Pediatric wide-field fundus photograph:
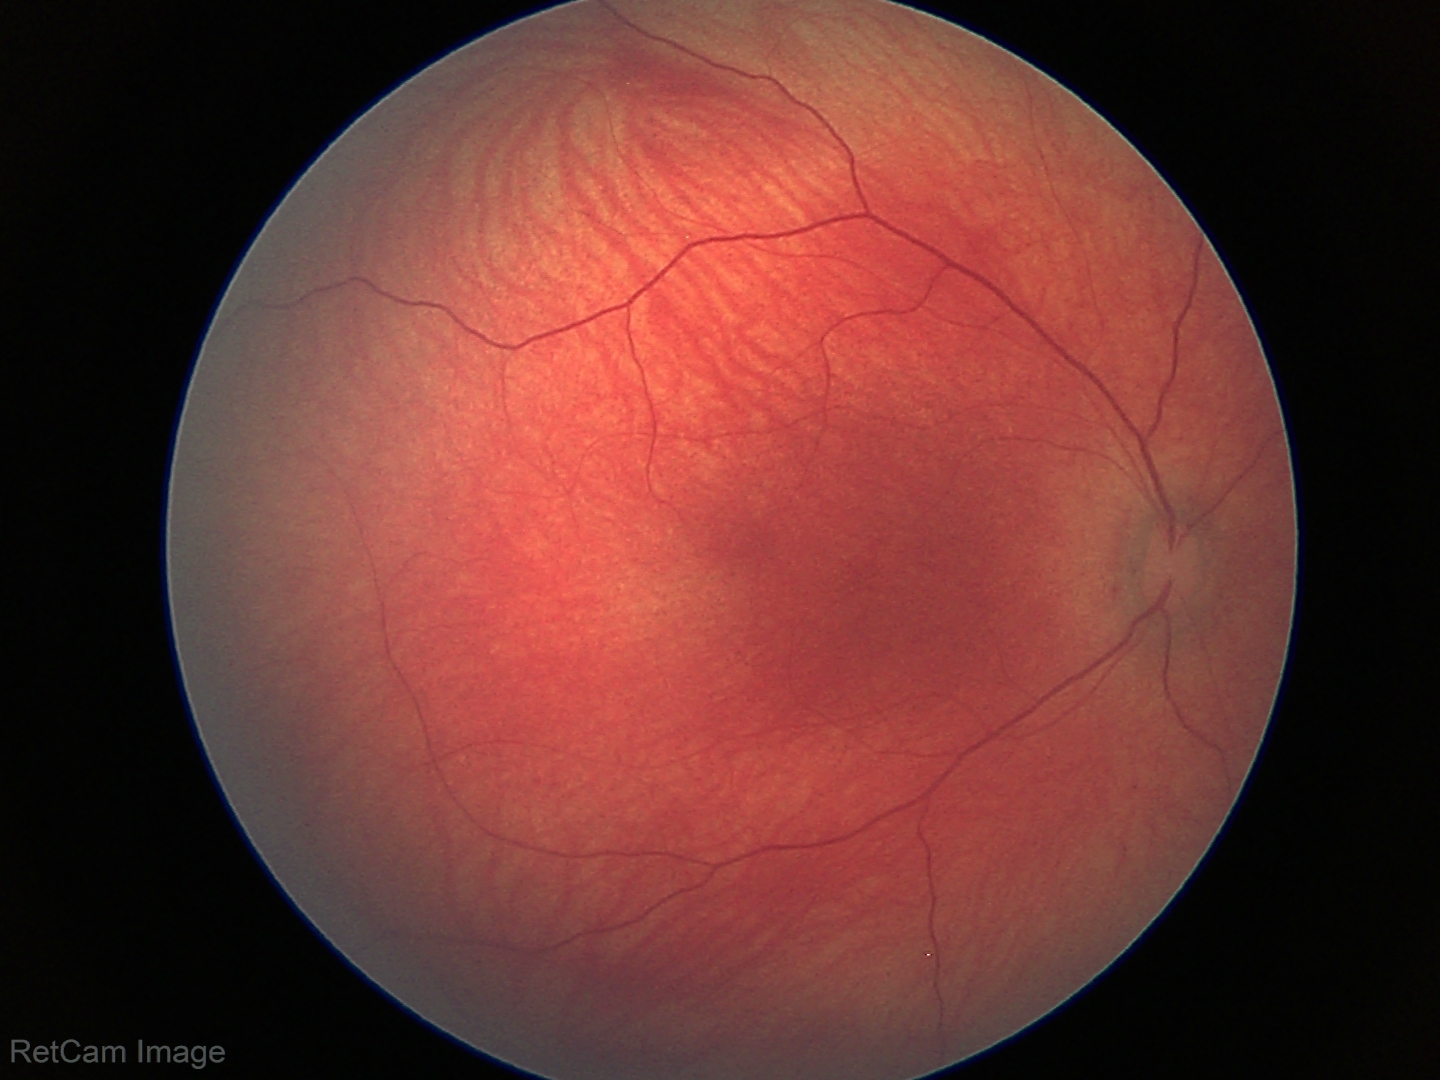 Screening examination diagnosed as physiological.